640x480. Wide-field fundus image from infant ROP screening. Captured with the Clarity RetCam 3 (130° field of view) — 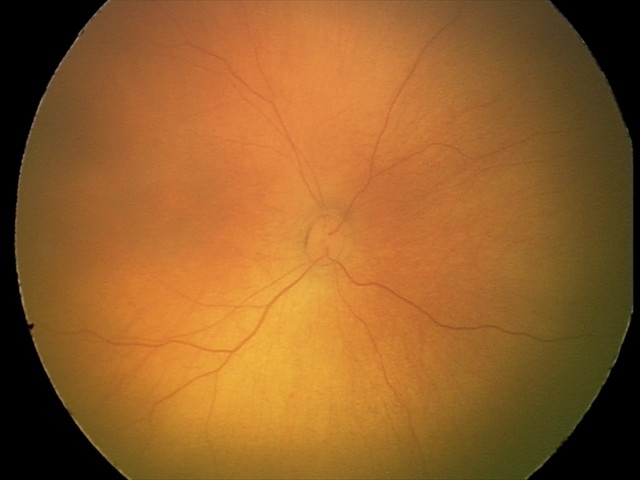 Physiological retinal appearance for postconceptual age.